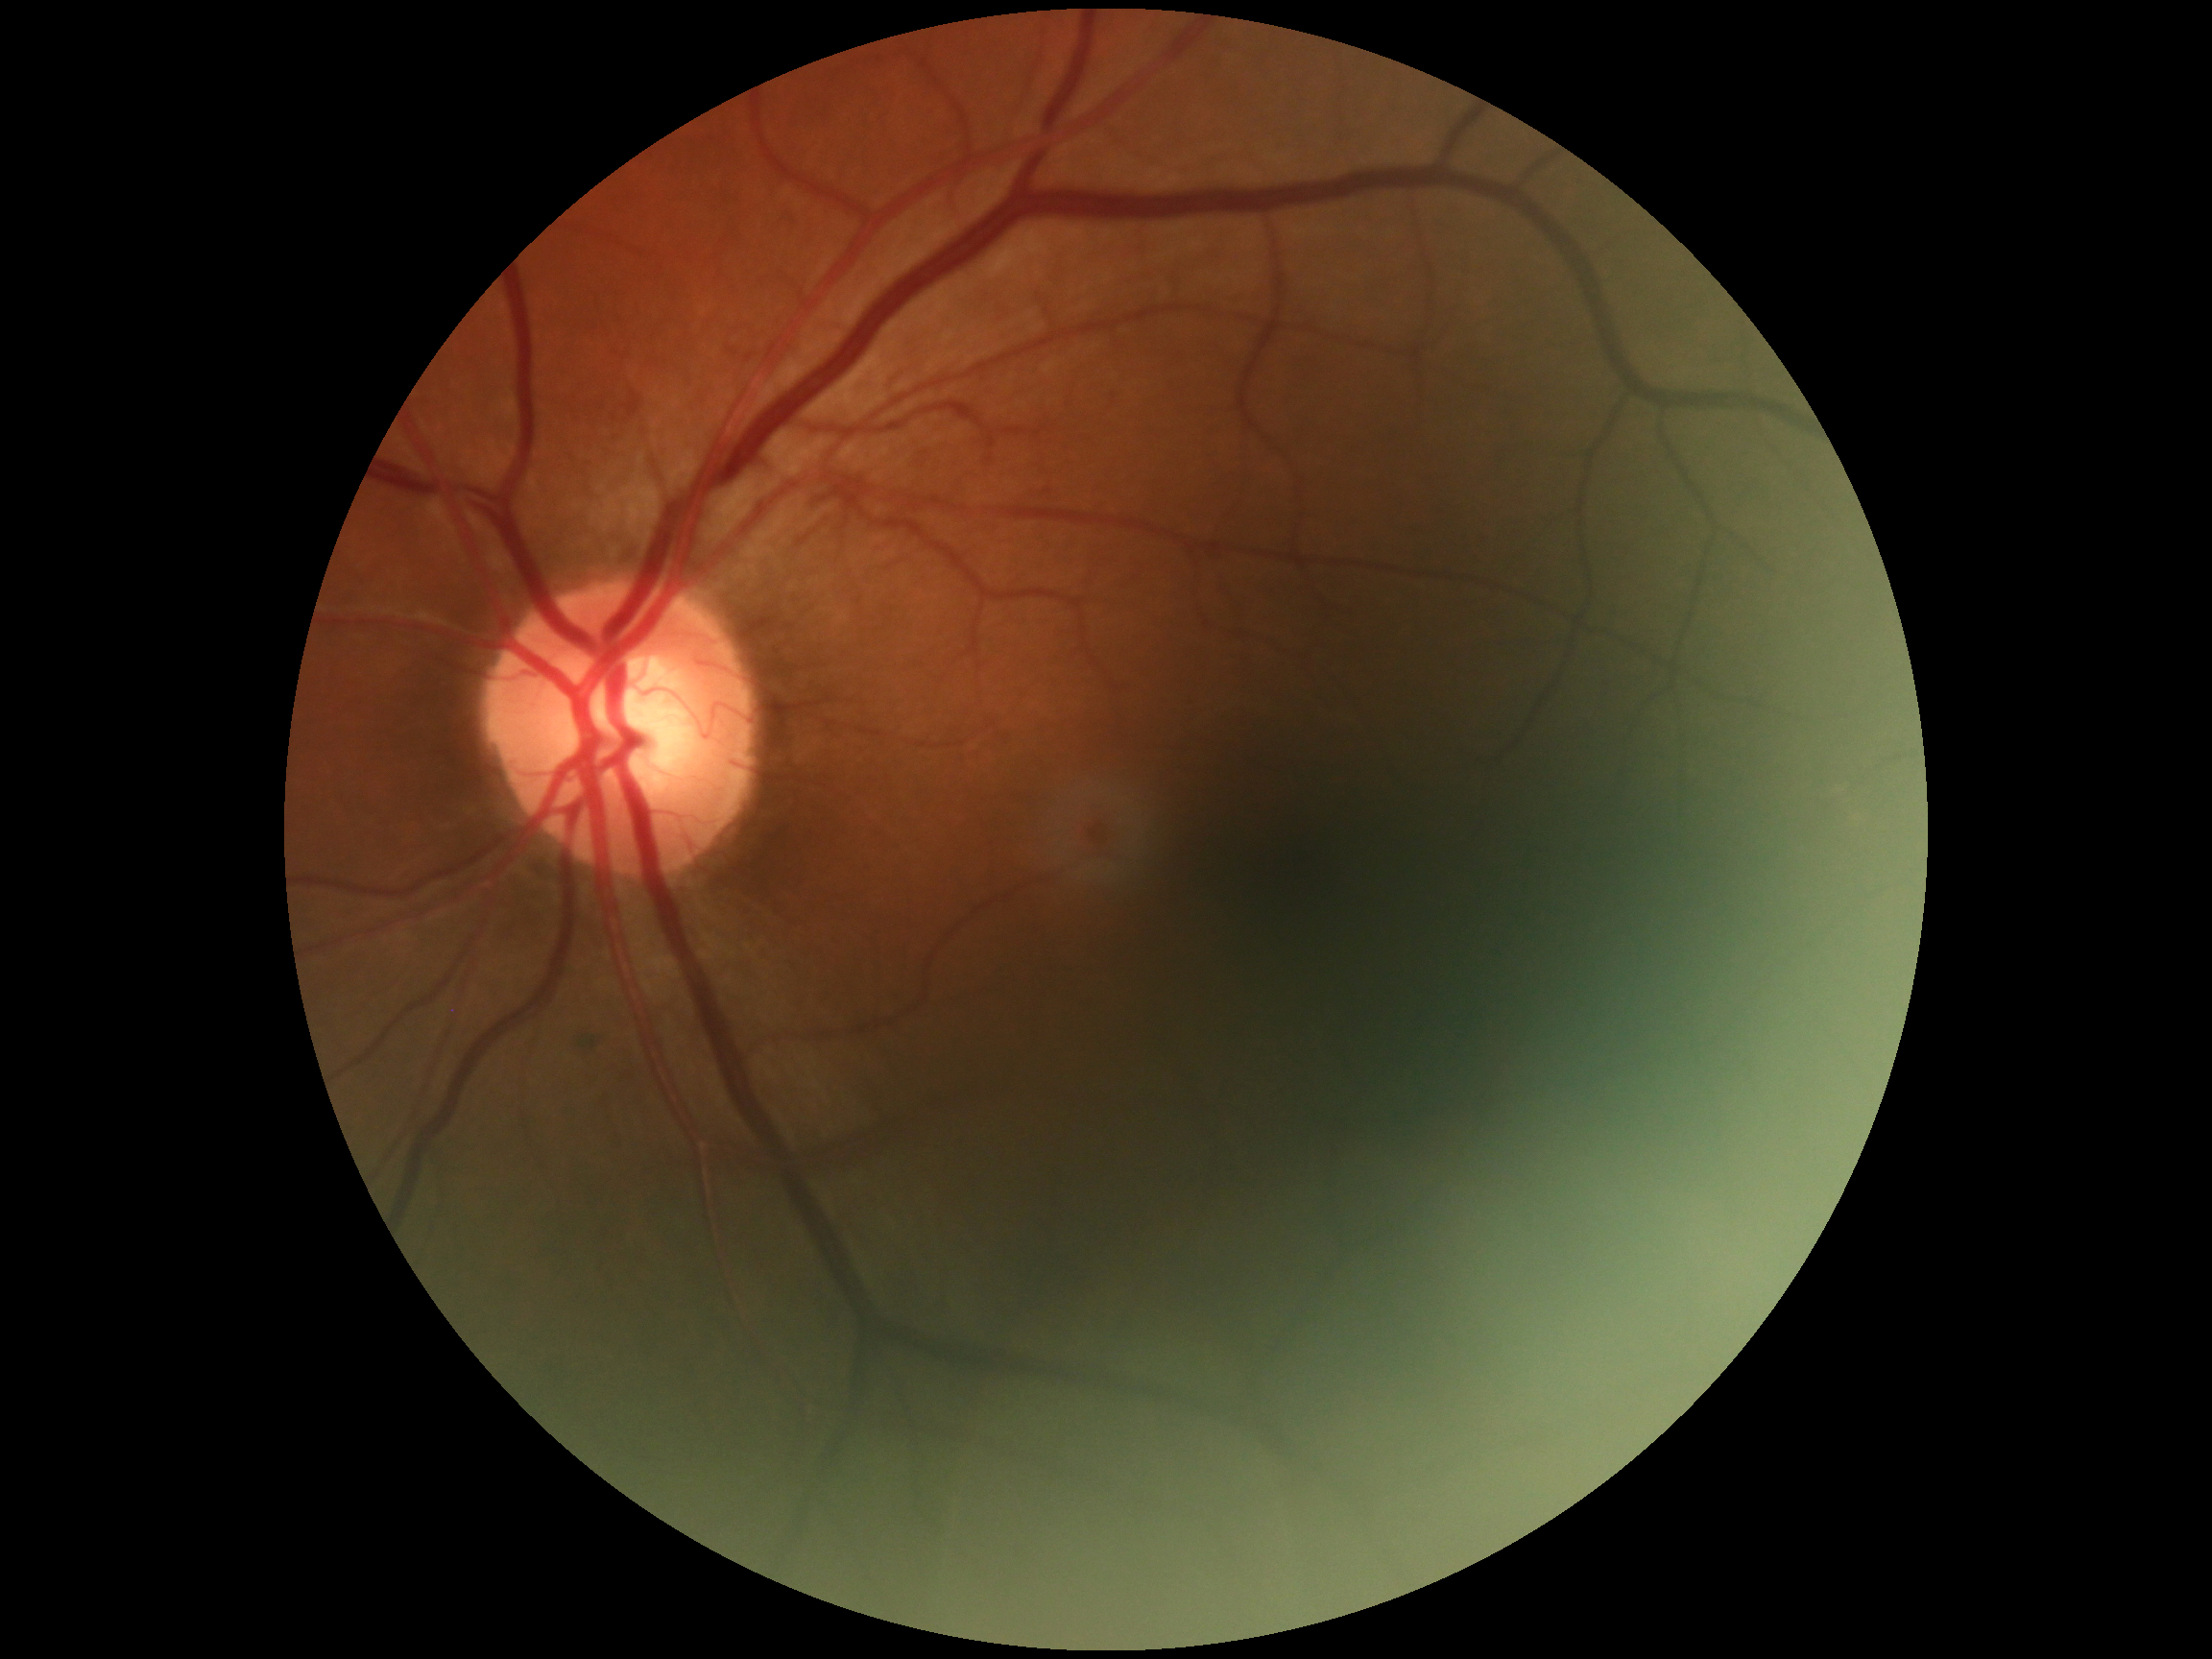
DR grade: moderate non-proliferative diabetic retinopathy (2).